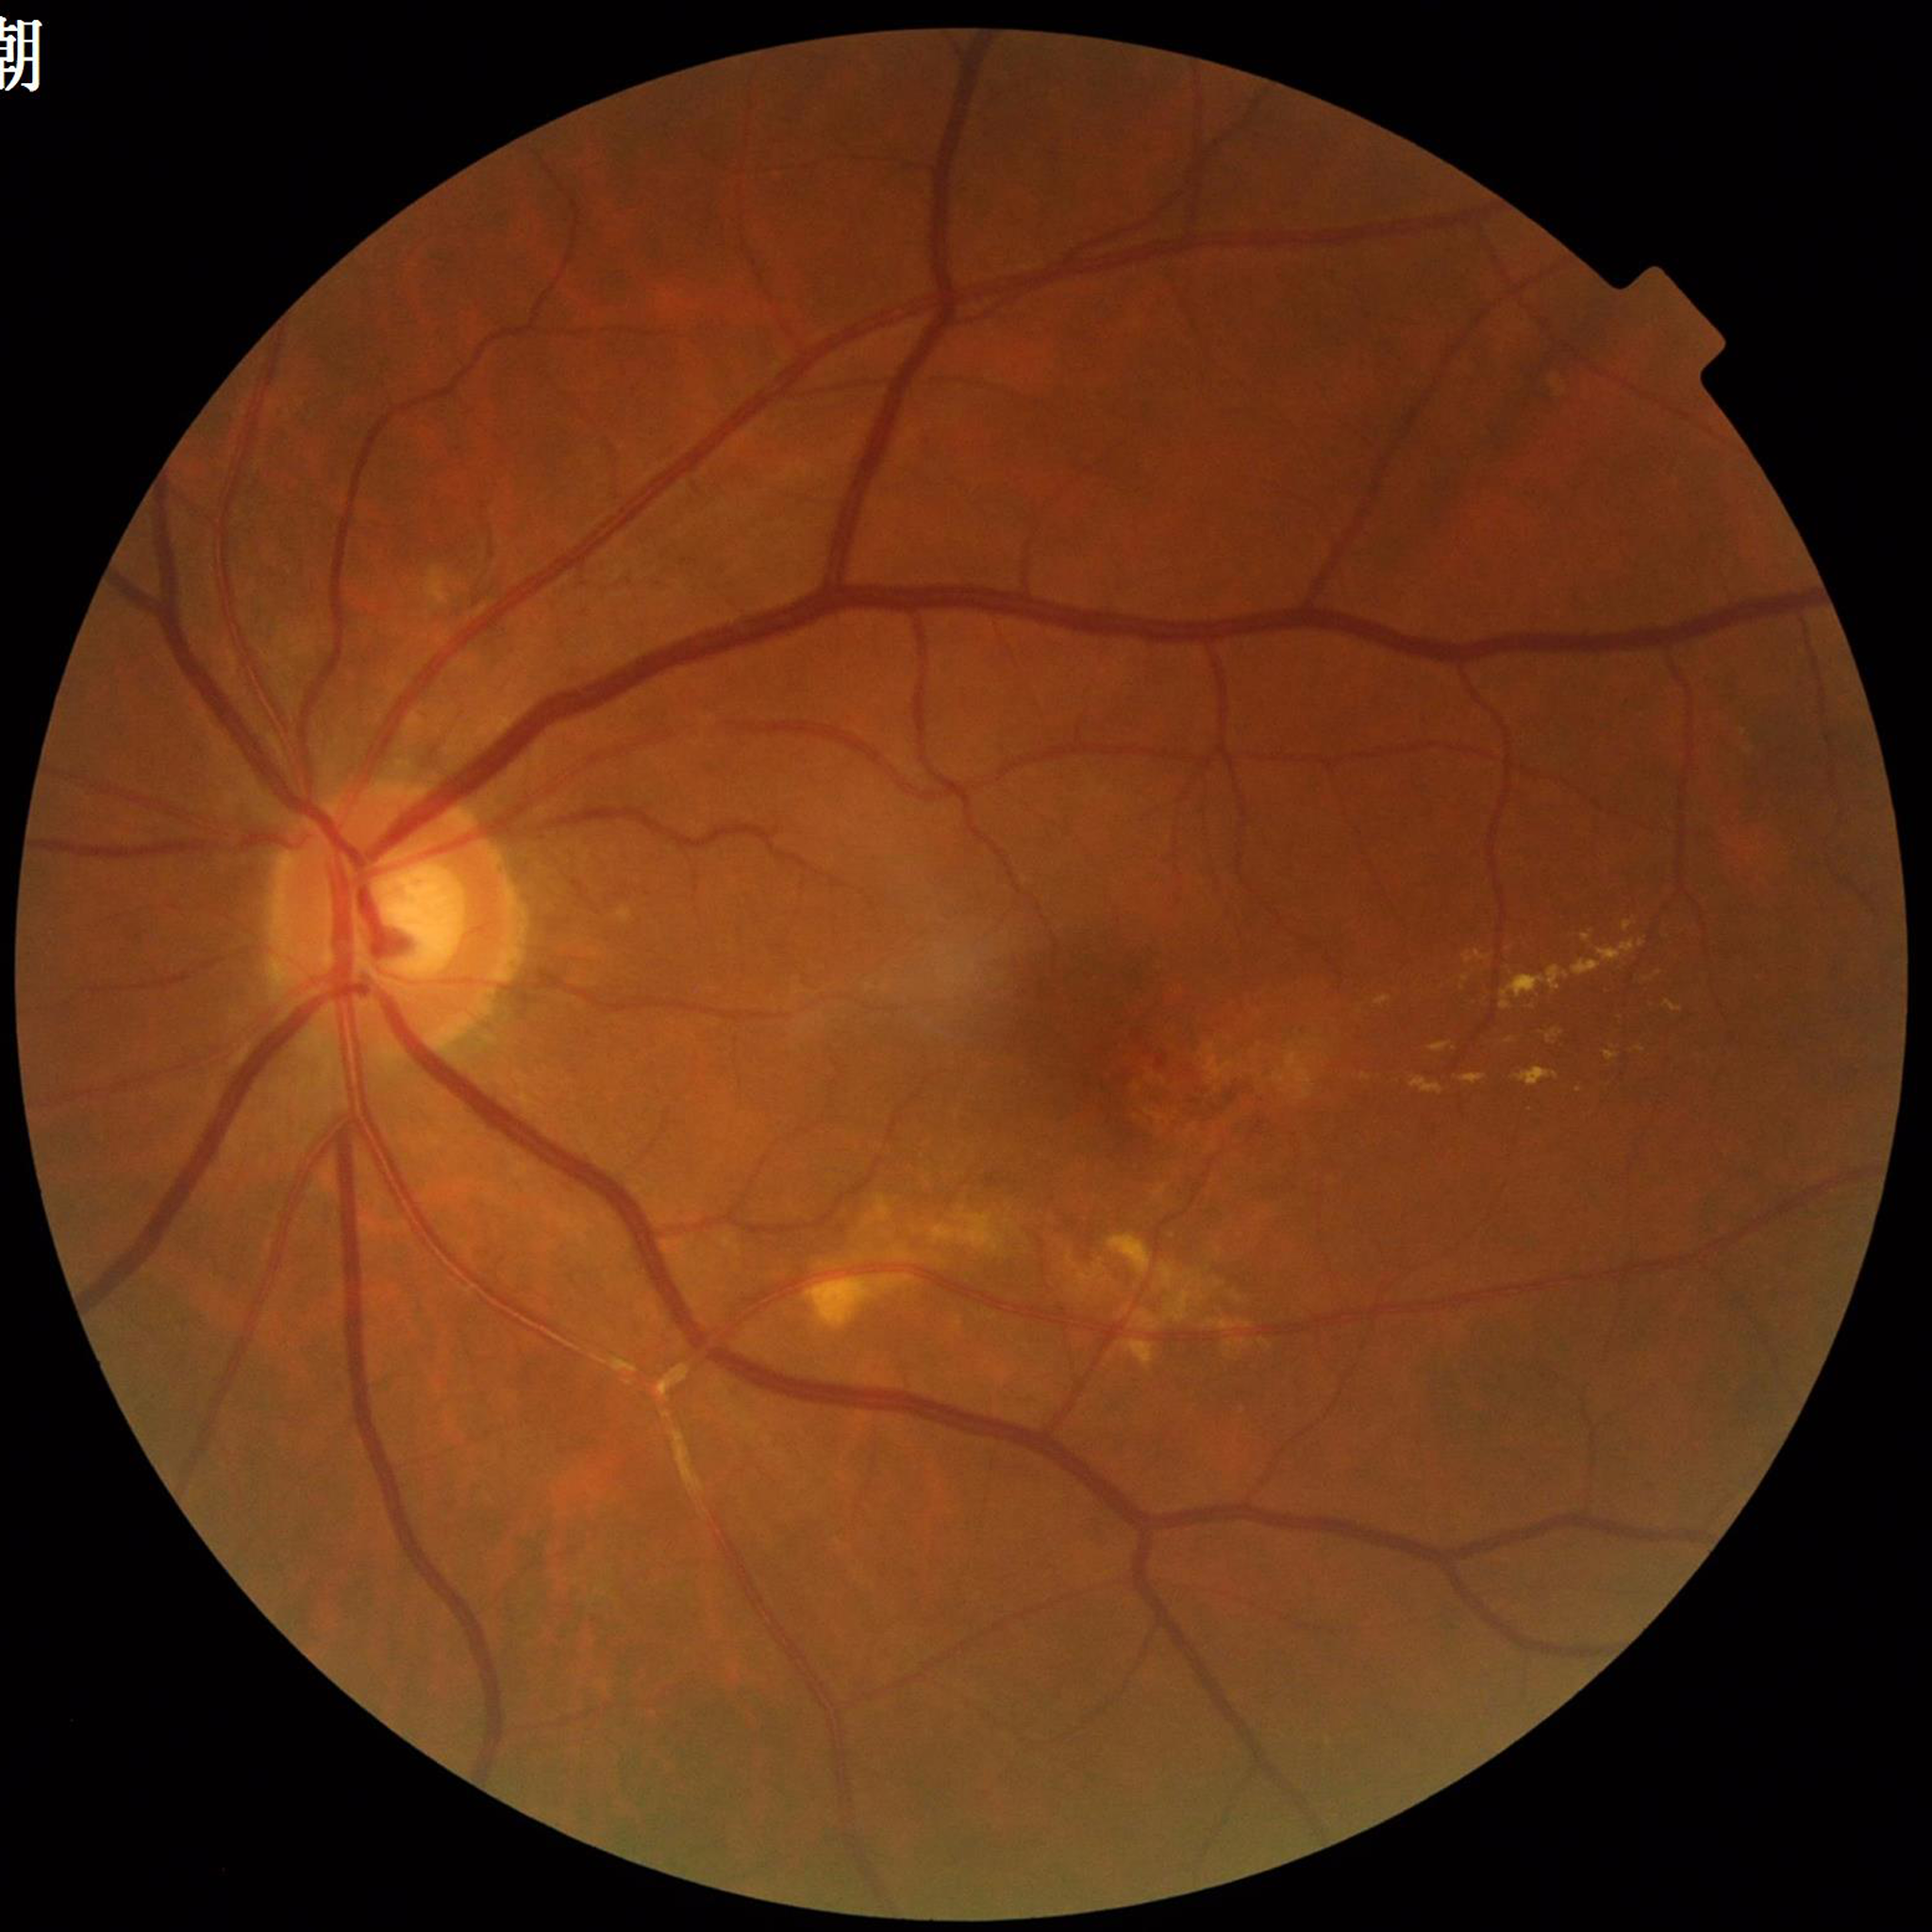
Eye affected by age-related macular degeneration (AMD).
Quality assessment: no quality issues identified.